Wide-field fundus image from infant ROP screening; acquired on the Clarity RetCam 3; 640x480px.
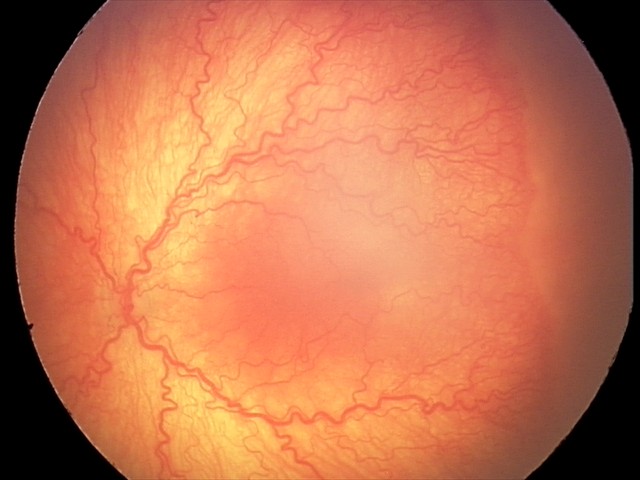

Screening diagnosis: aggressive retinopathy of prematurity — rapidly progressive severe ROP with prominent plus disease, often without classic stage progression; plus disease.